Diabetic retinopathy graded by the modified Davis classification. Acquired with a NIDEK AFC-230.
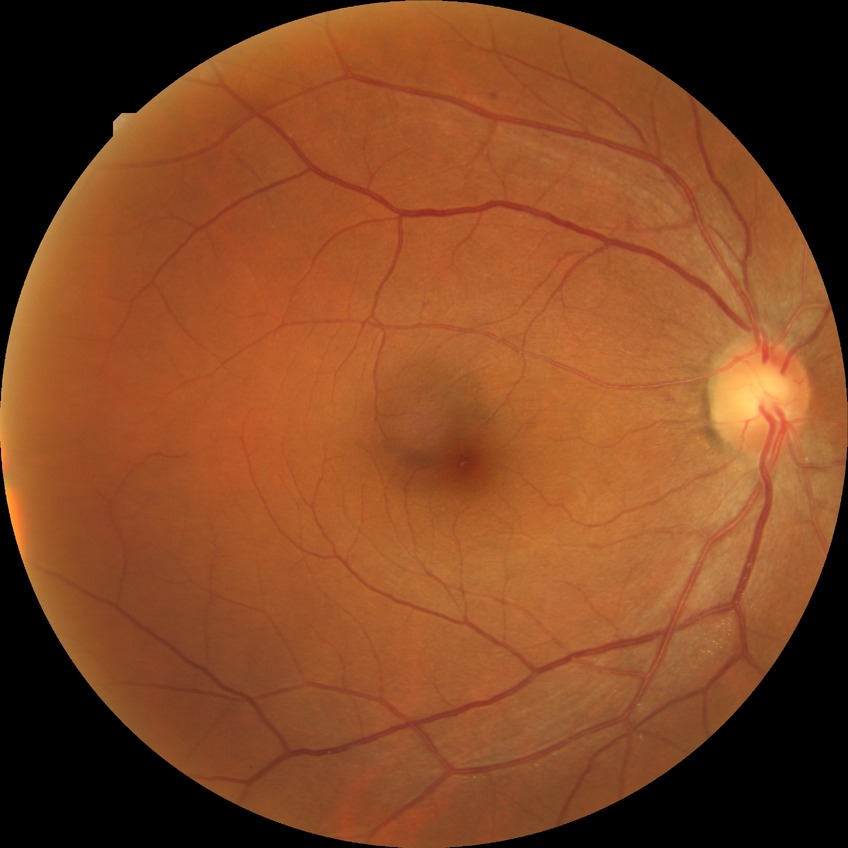 diabetic retinopathy grade = simple diabetic retinopathy.